Nonmydriatic fundus photograph — 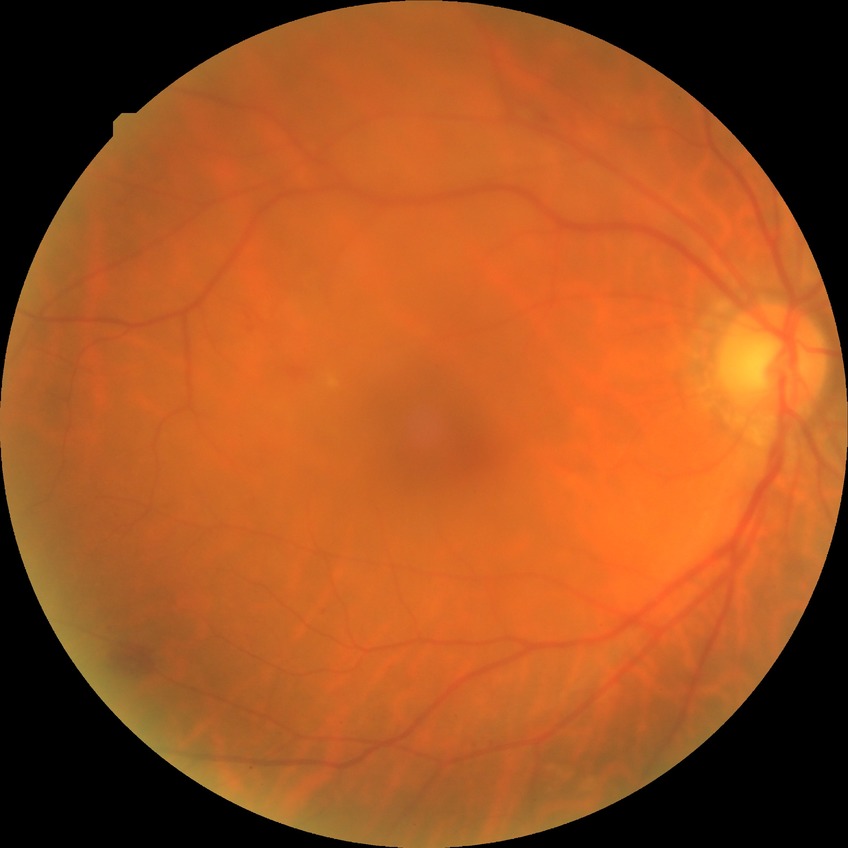 Diabetic retinopathy (DR) is no diabetic retinopathy (NDR).